Nonmydriatic, 848x848px, posterior pole color fundus photograph.
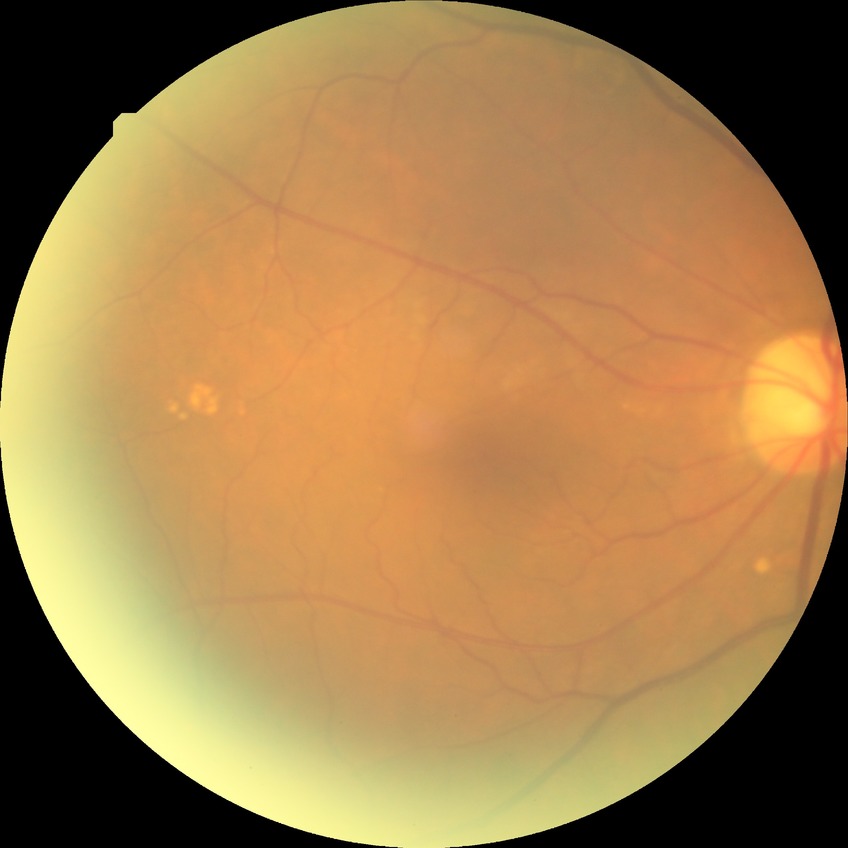
Annotations:
* retinopathy grade: no diabetic retinopathy